Infant wide-field retinal image.
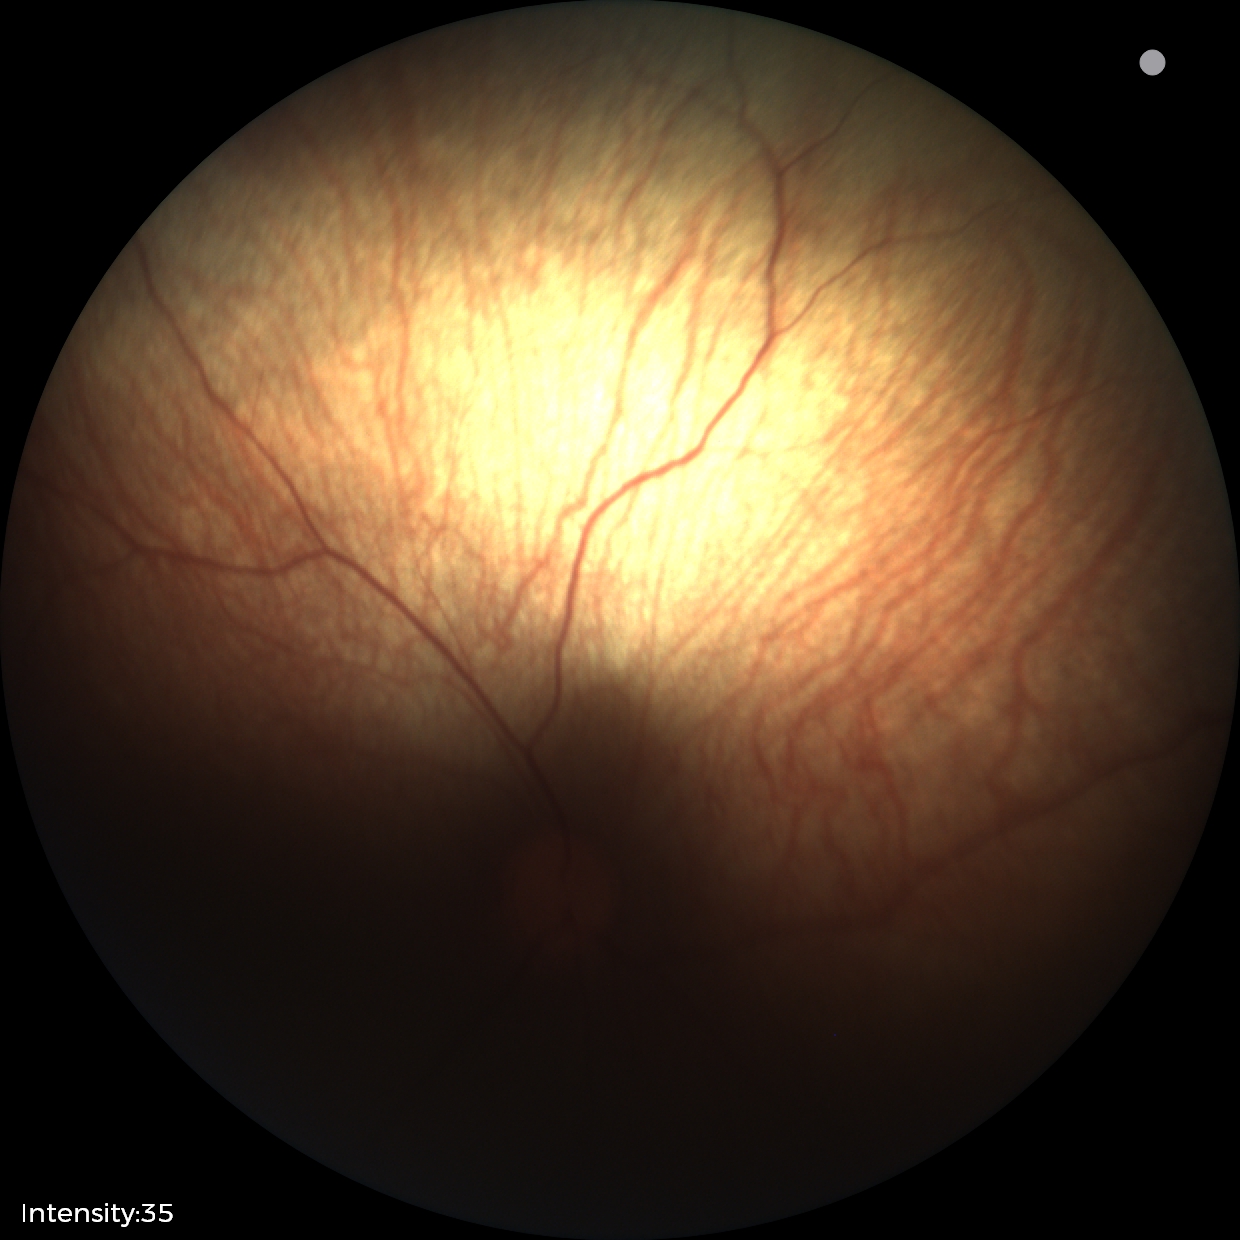
Screening examination with no abnormal retinal findings.